Non-mydriatic acquisition · captured on a Nidek AFC-330 fundus camera · color fundus image — 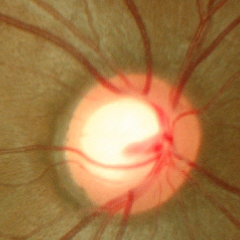
Showing no glaucomatous findings.